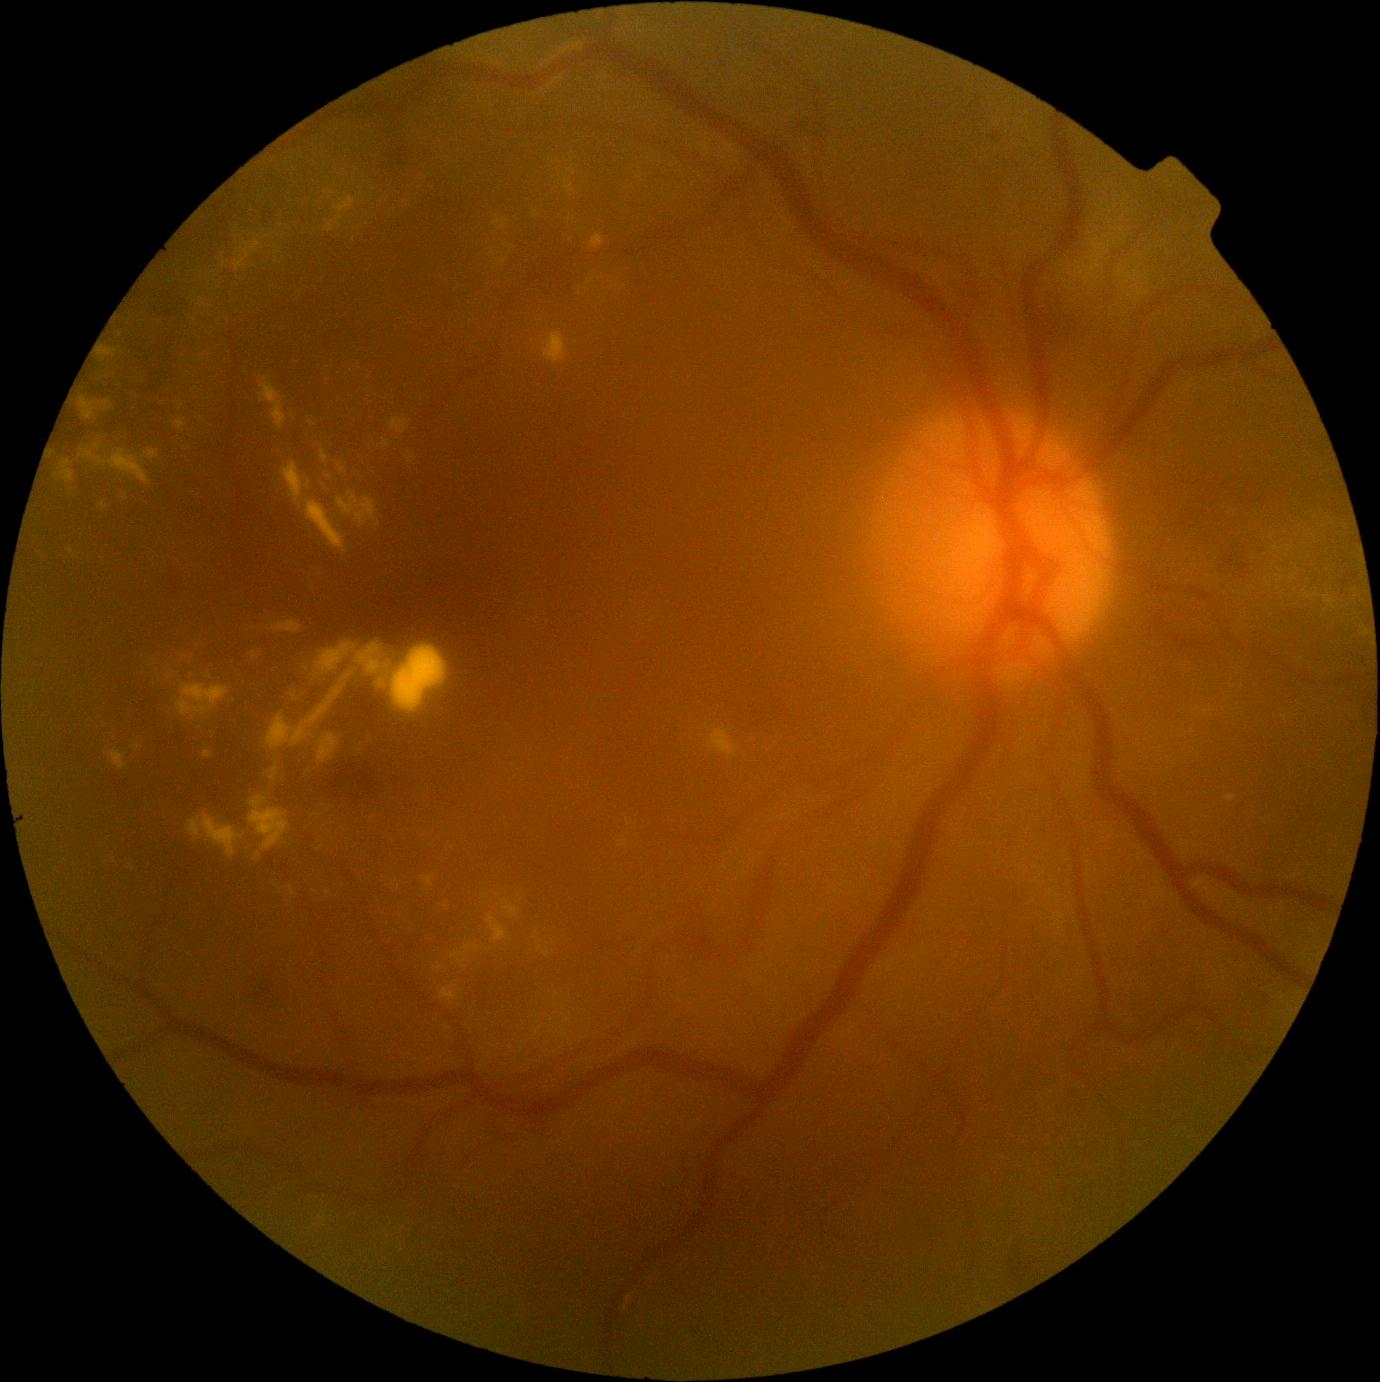 Diabetic retinopathy: grade 2 (moderate NPDR) — more than just microaneurysms but less than severe NPDR
Representative lesions:
microaneurysms: bbox(988, 133, 1004, 143)
soft exudates: absent
hemorrhages: bbox(326, 760, 383, 806) | bbox(64, 415, 75, 431) | bbox(1237, 562, 1253, 577) | bbox(443, 297, 453, 310) | bbox(1008, 1246, 1041, 1286) | bbox(529, 251, 580, 291) | bbox(58, 418, 87, 444) | bbox(253, 974, 276, 1006) | bbox(155, 334, 177, 357) | bbox(249, 978, 260, 985) | bbox(389, 147, 410, 174) | bbox(141, 369, 163, 396) | bbox(159, 290, 188, 317) | bbox(1221, 551, 1245, 566)
hard exudates (continued): bbox(1325, 596, 1336, 608) | bbox(565, 180, 575, 196) | bbox(489, 915, 507, 944) | bbox(254, 853, 262, 861) | bbox(390, 418, 410, 434) | bbox(268, 641, 448, 750) | bbox(235, 240, 262, 273) | bbox(588, 278, 596, 285) | bbox(176, 684, 231, 721) | bbox(464, 946, 480, 952) | bbox(266, 764, 280, 781)
Small hard exudates approximately at (540,948) | (310,423) | (410,453) | (711,729) | (446,907) | (504,261) | (132,867)